848x848px, without pupil dilation
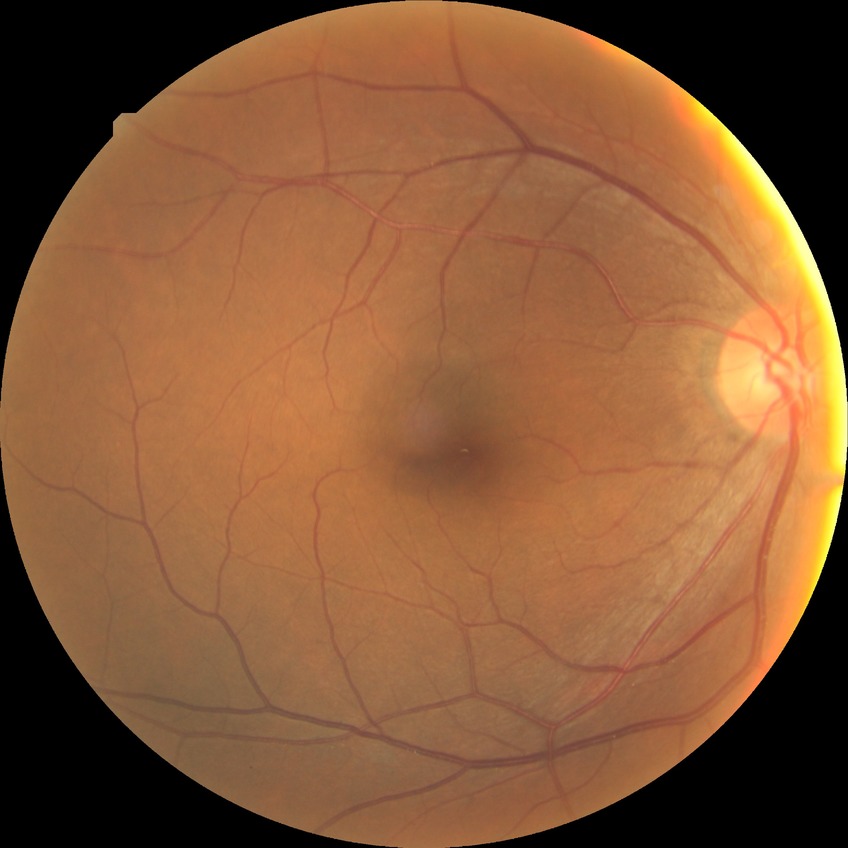 DR stage: NDR.